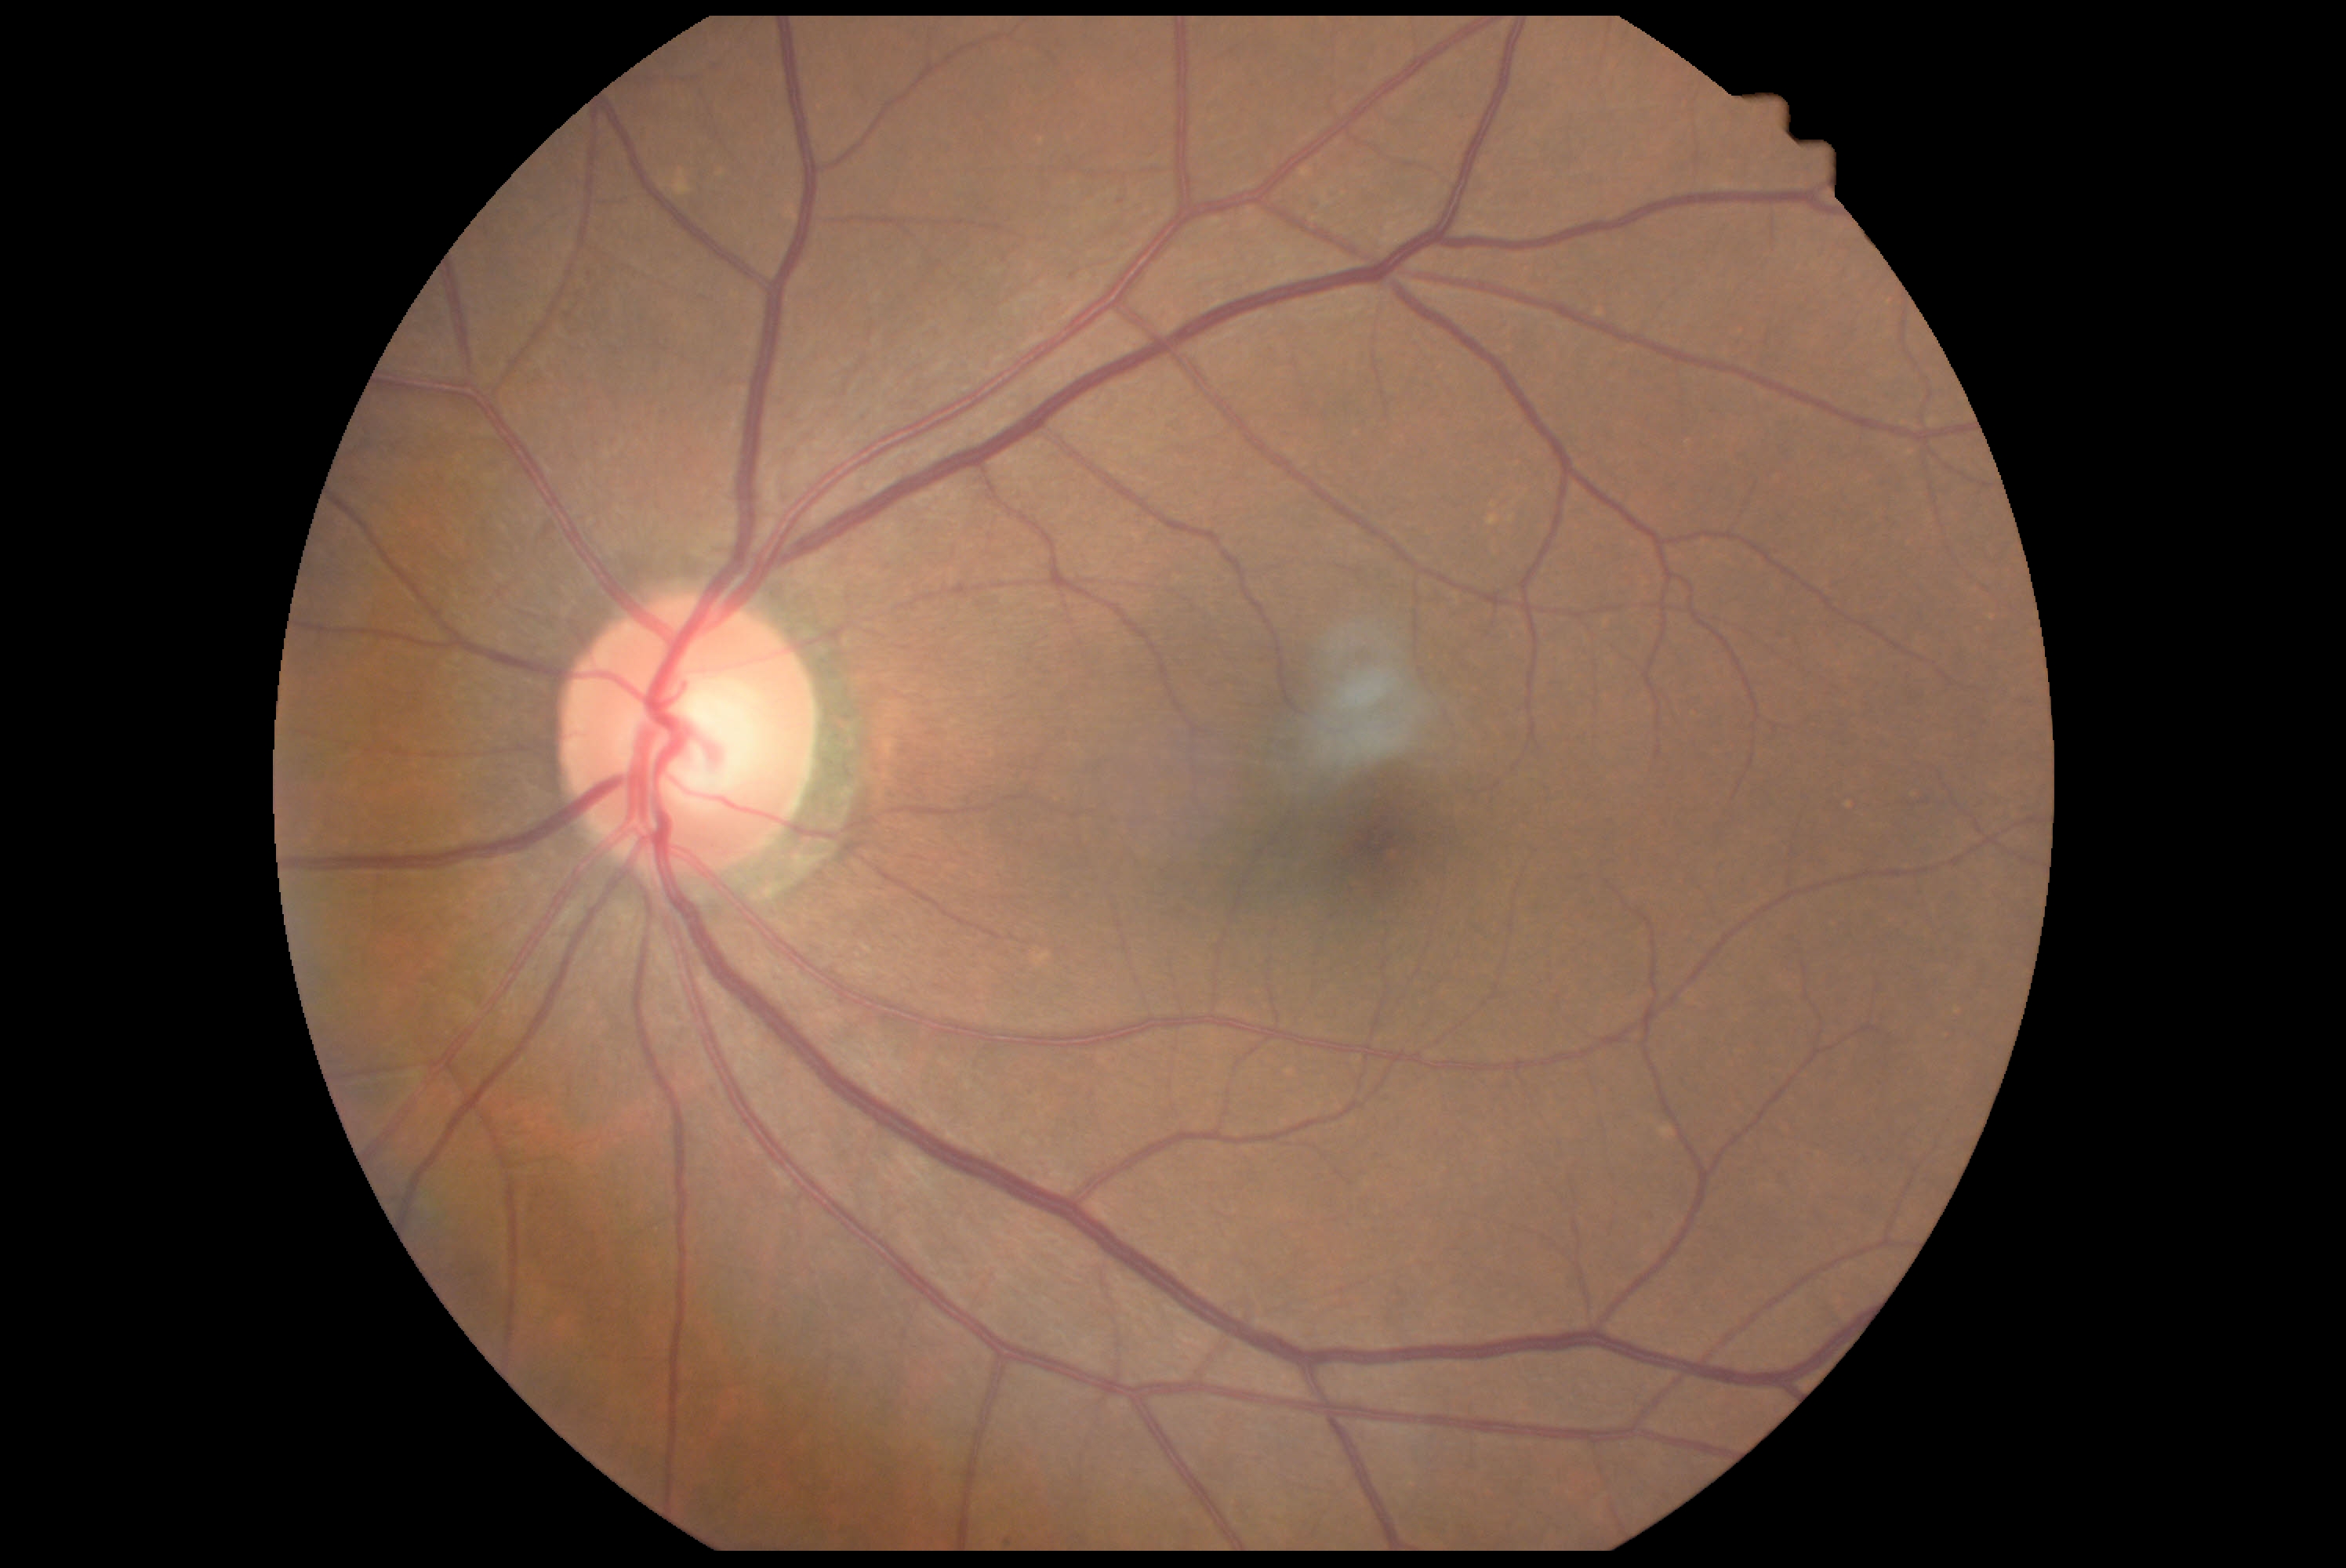
Findings:
* diabetic retinopathy (DR): grade 0 — no visible signs of diabetic retinopathy